2352 by 1568 pixels, fundus photo:
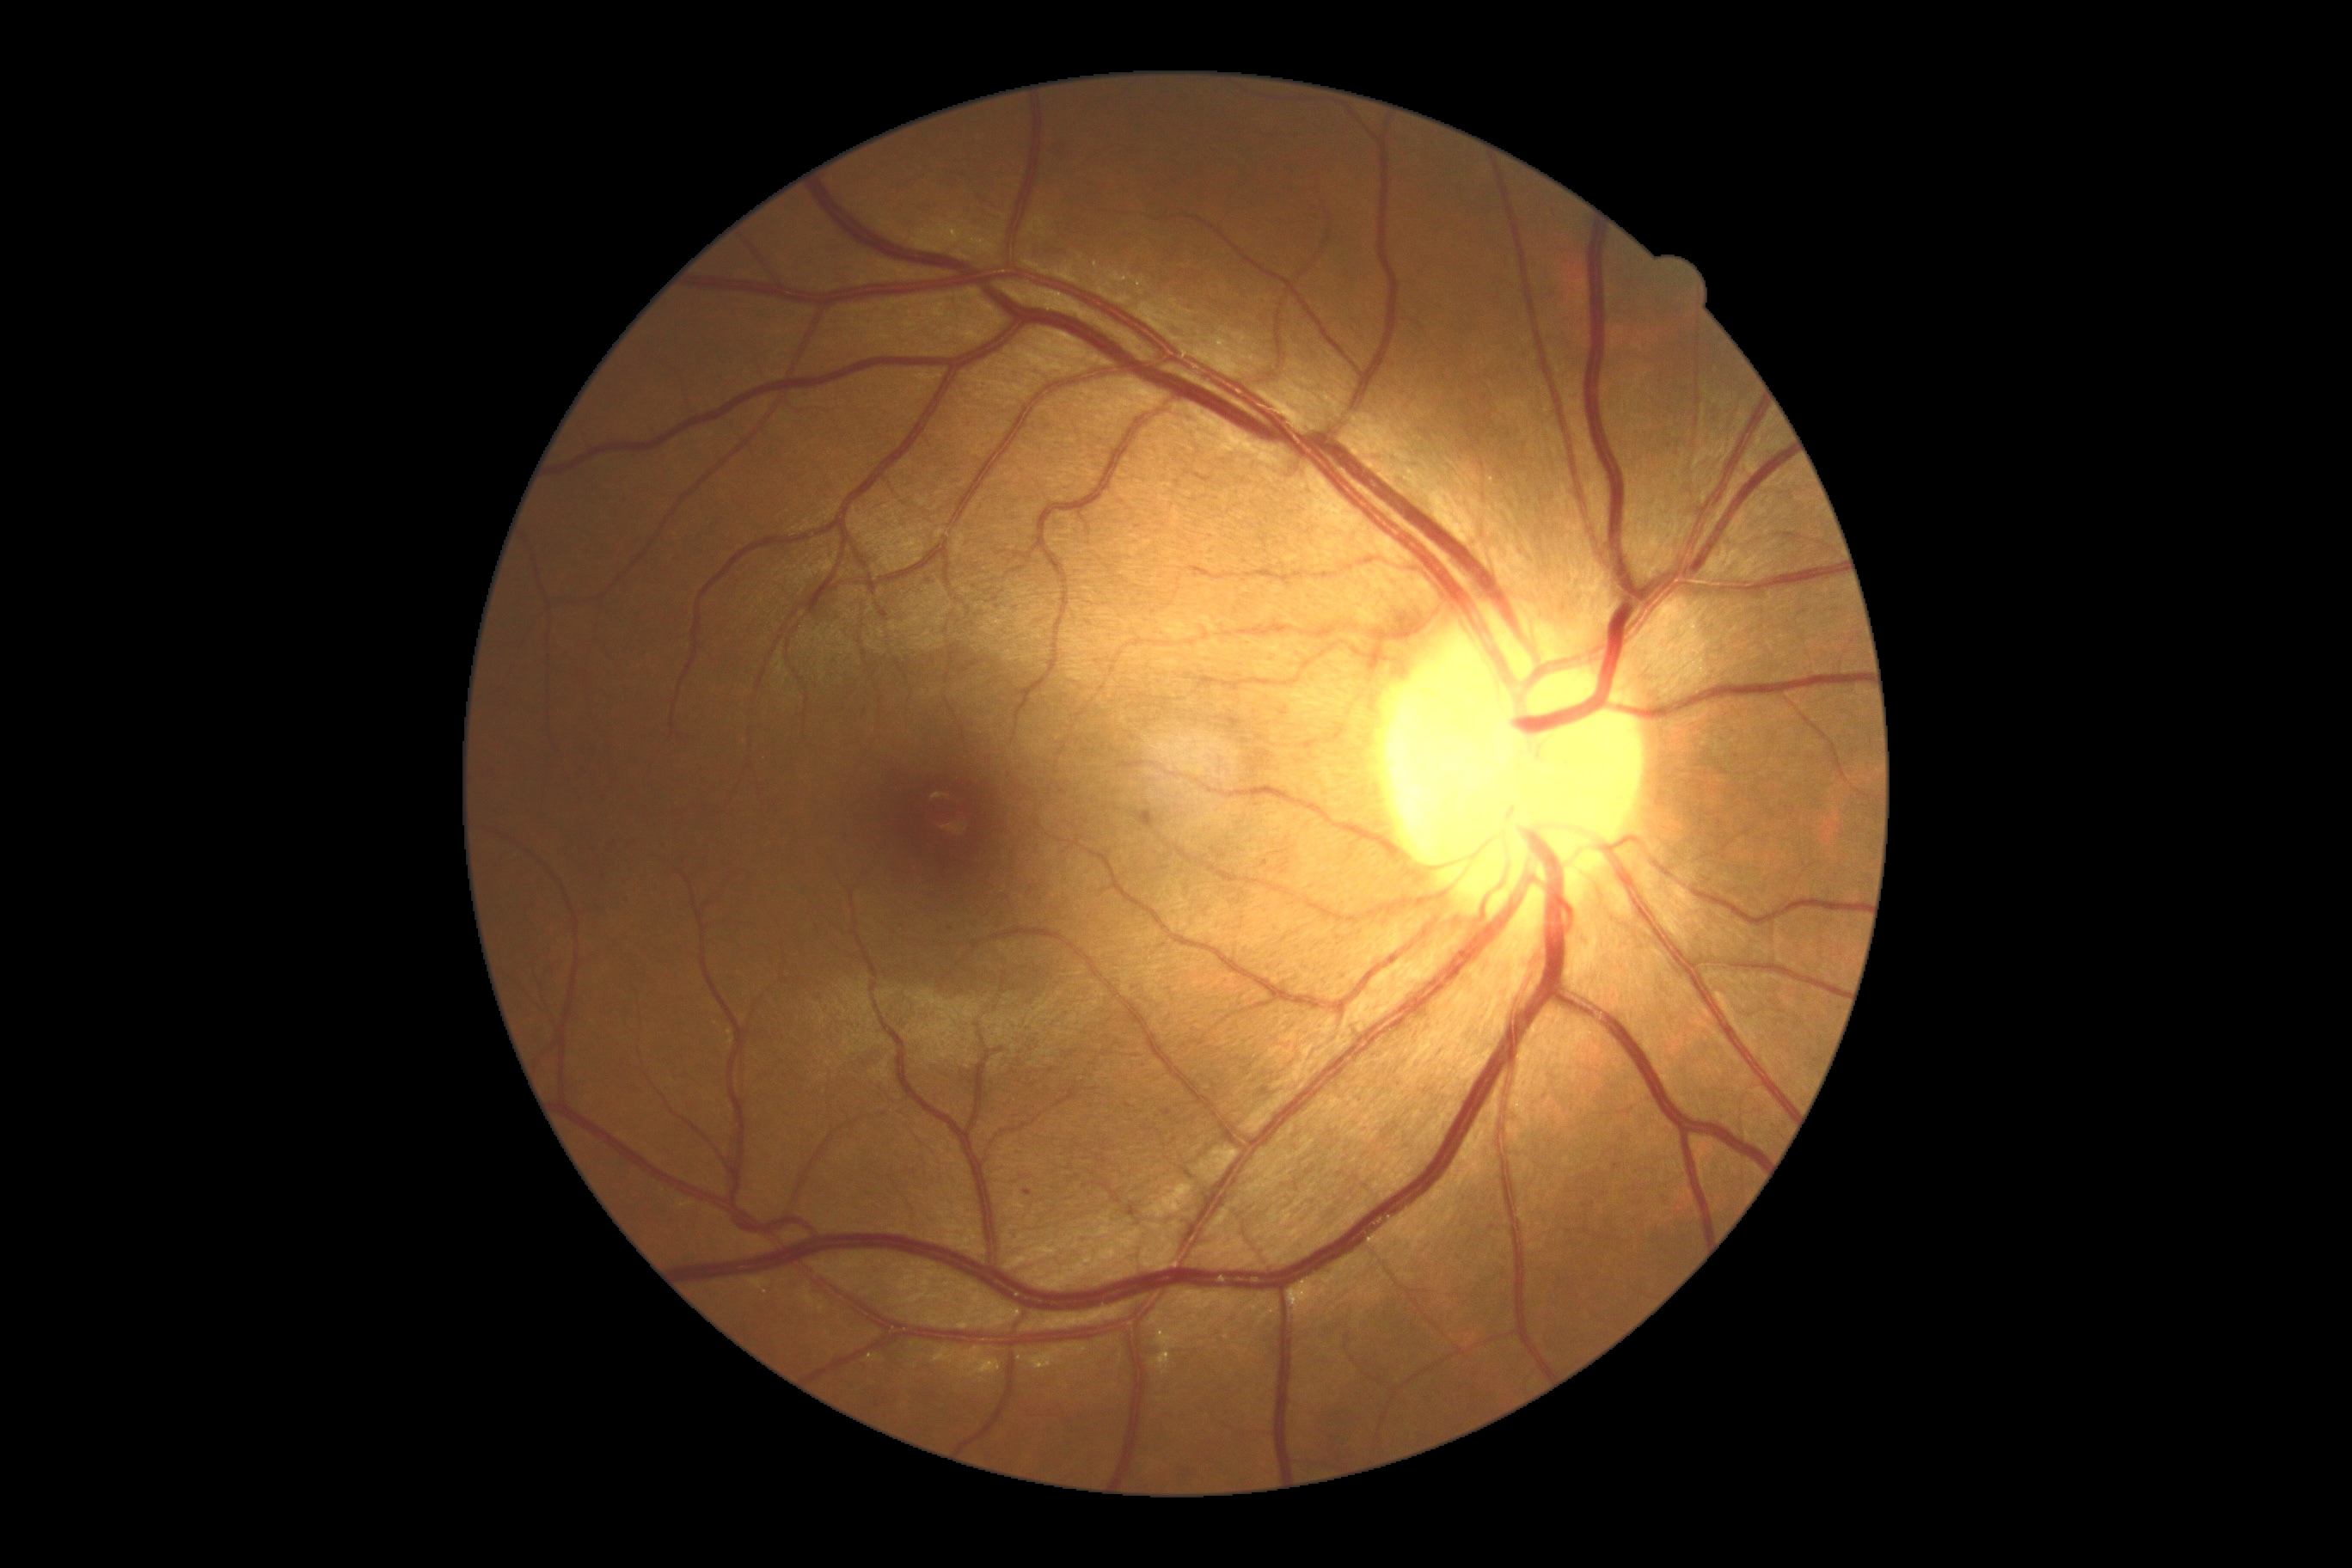
DR severity = 1/4; DR class = non-proliferative diabetic retinopathy.